Modified Davis grading. 45 degree fundus photograph. CFP — 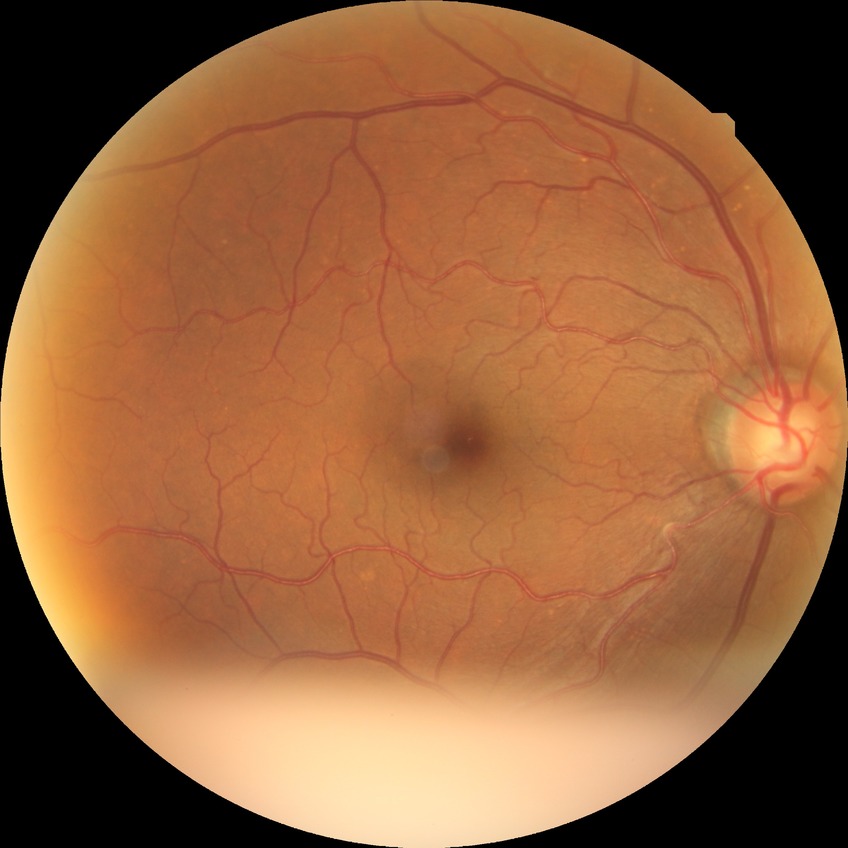 Diabetic retinopathy stage is no diabetic retinopathy.